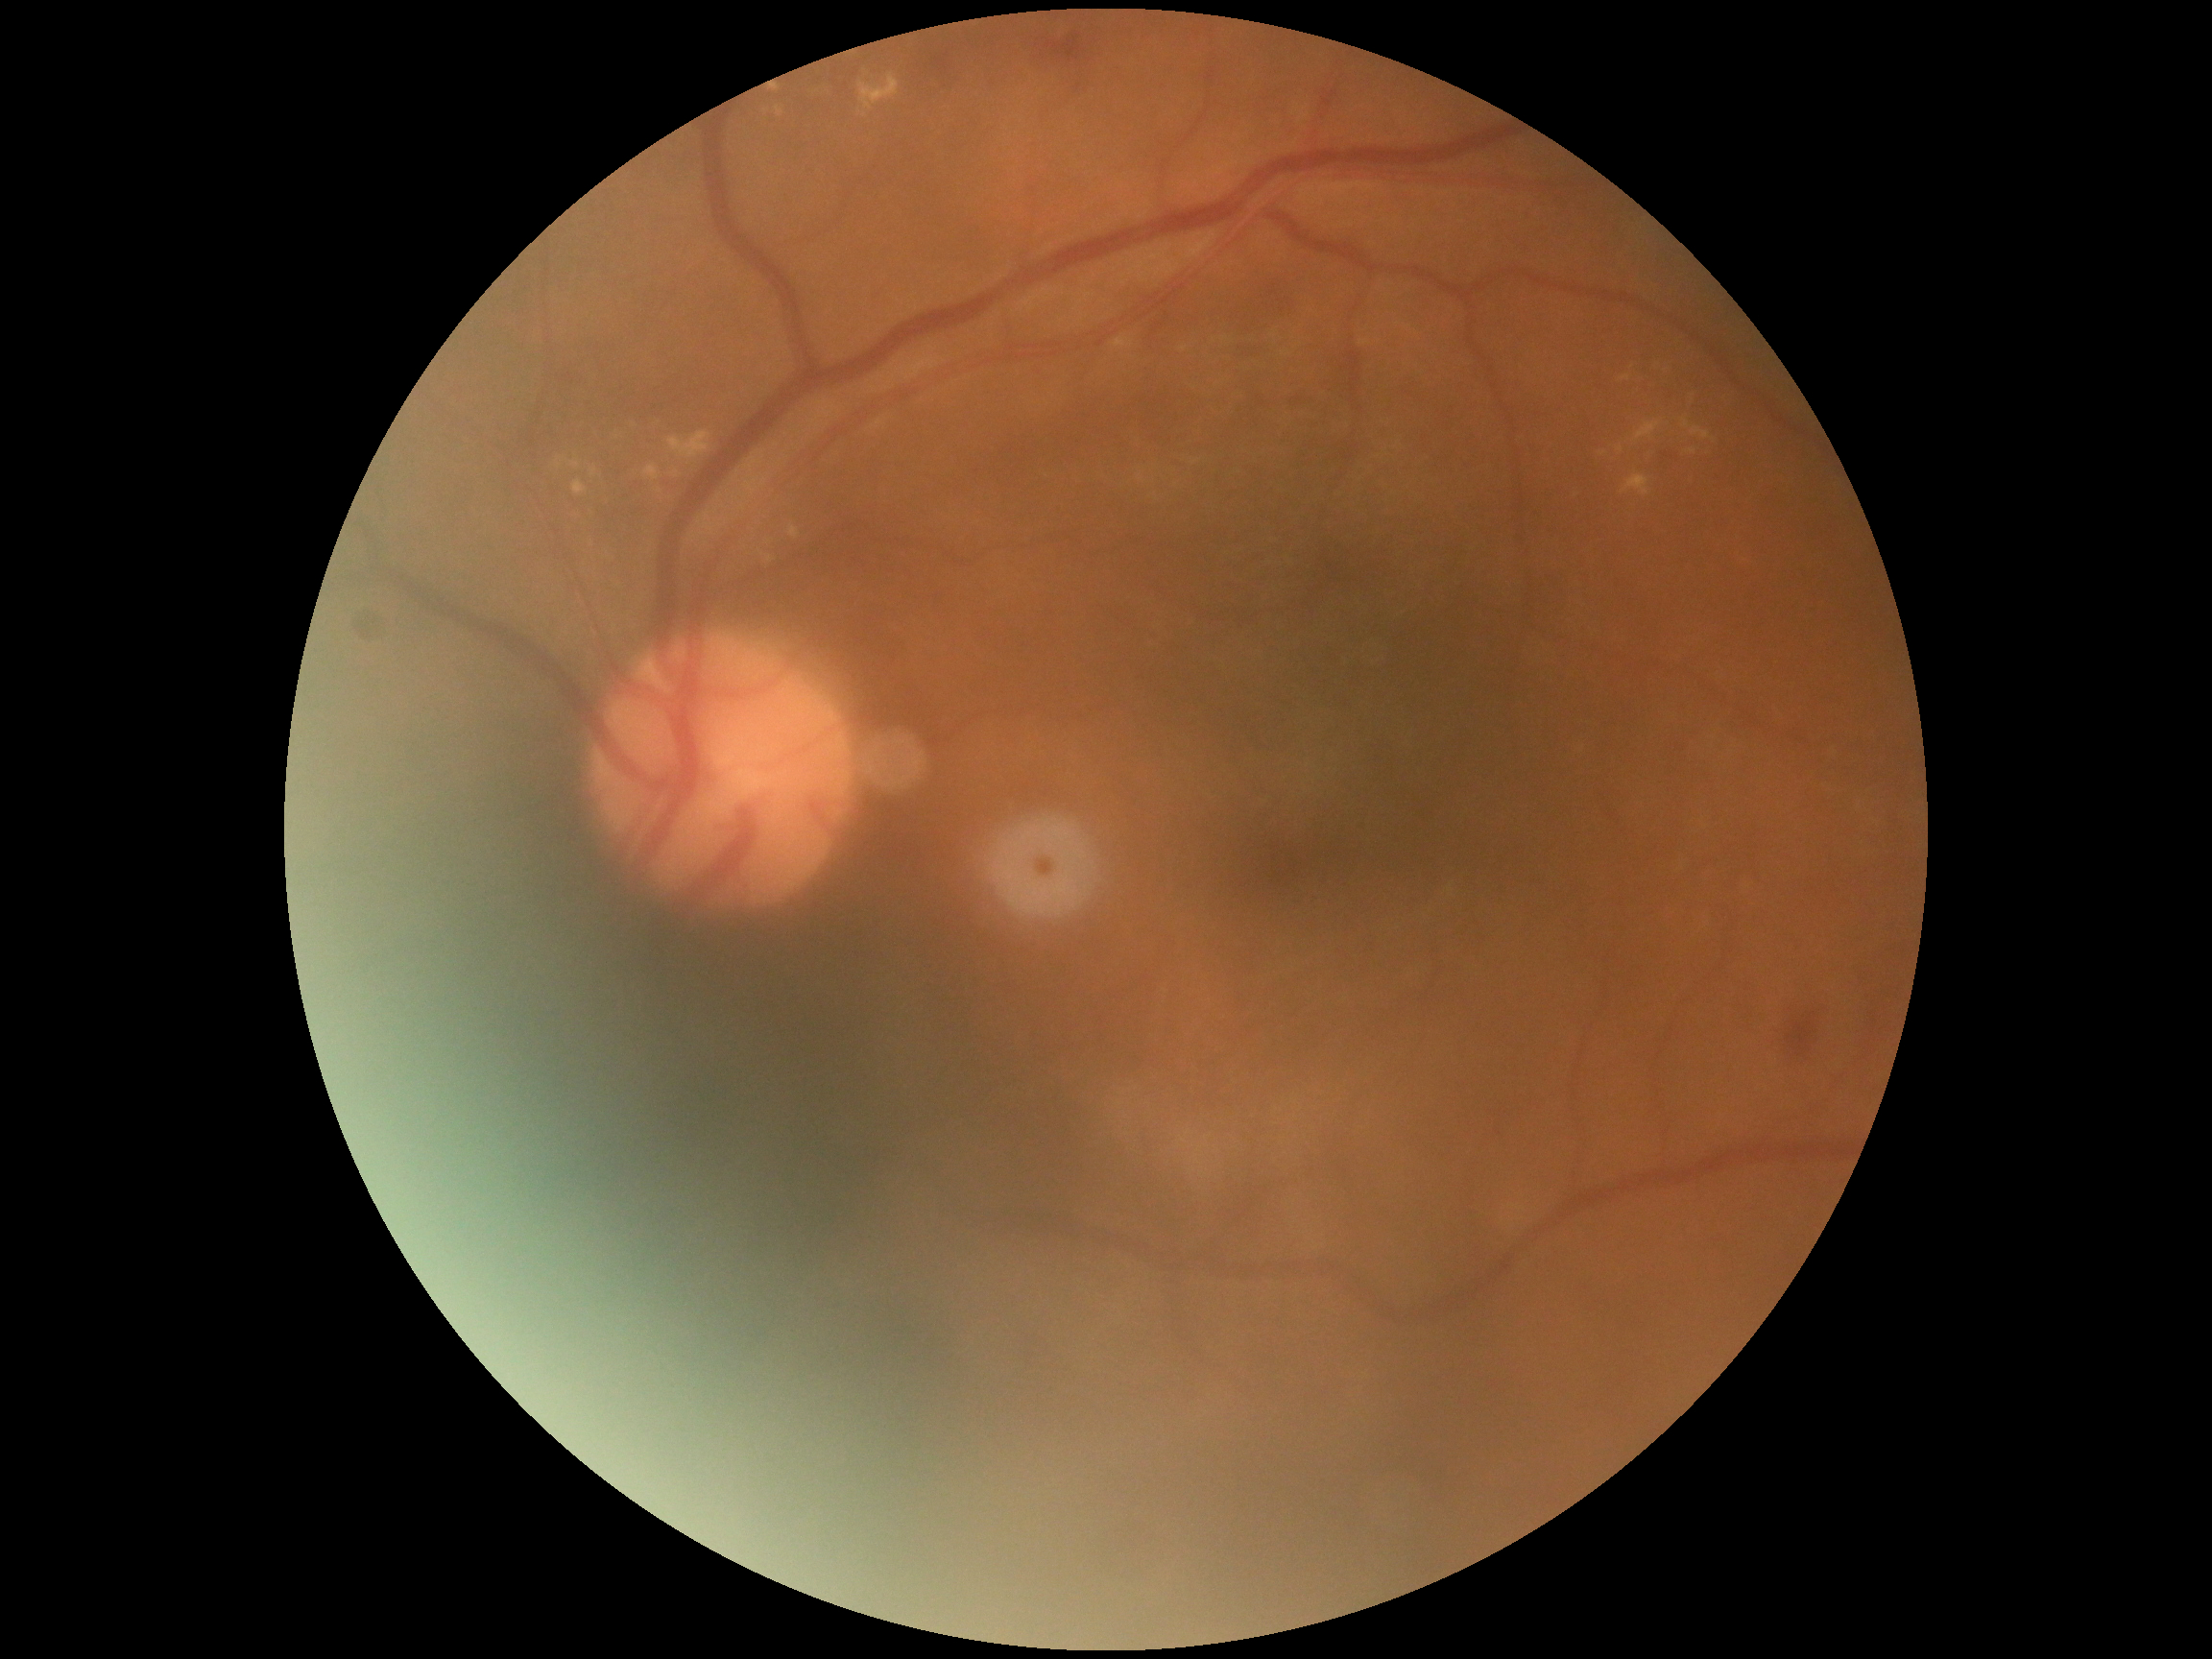

DR stage is 2. The retinopathy is classified as non-proliferative diabetic retinopathy.